Wide-field contact fundus photograph of an infant · 130° field of view (Clarity RetCam 3)
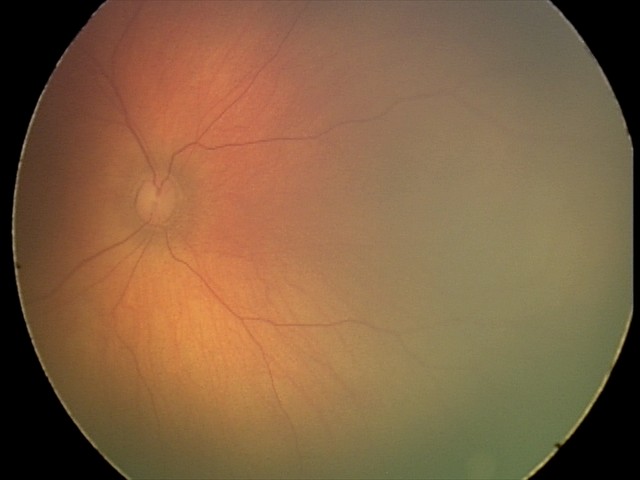 Screening examination diagnosed as physiological.